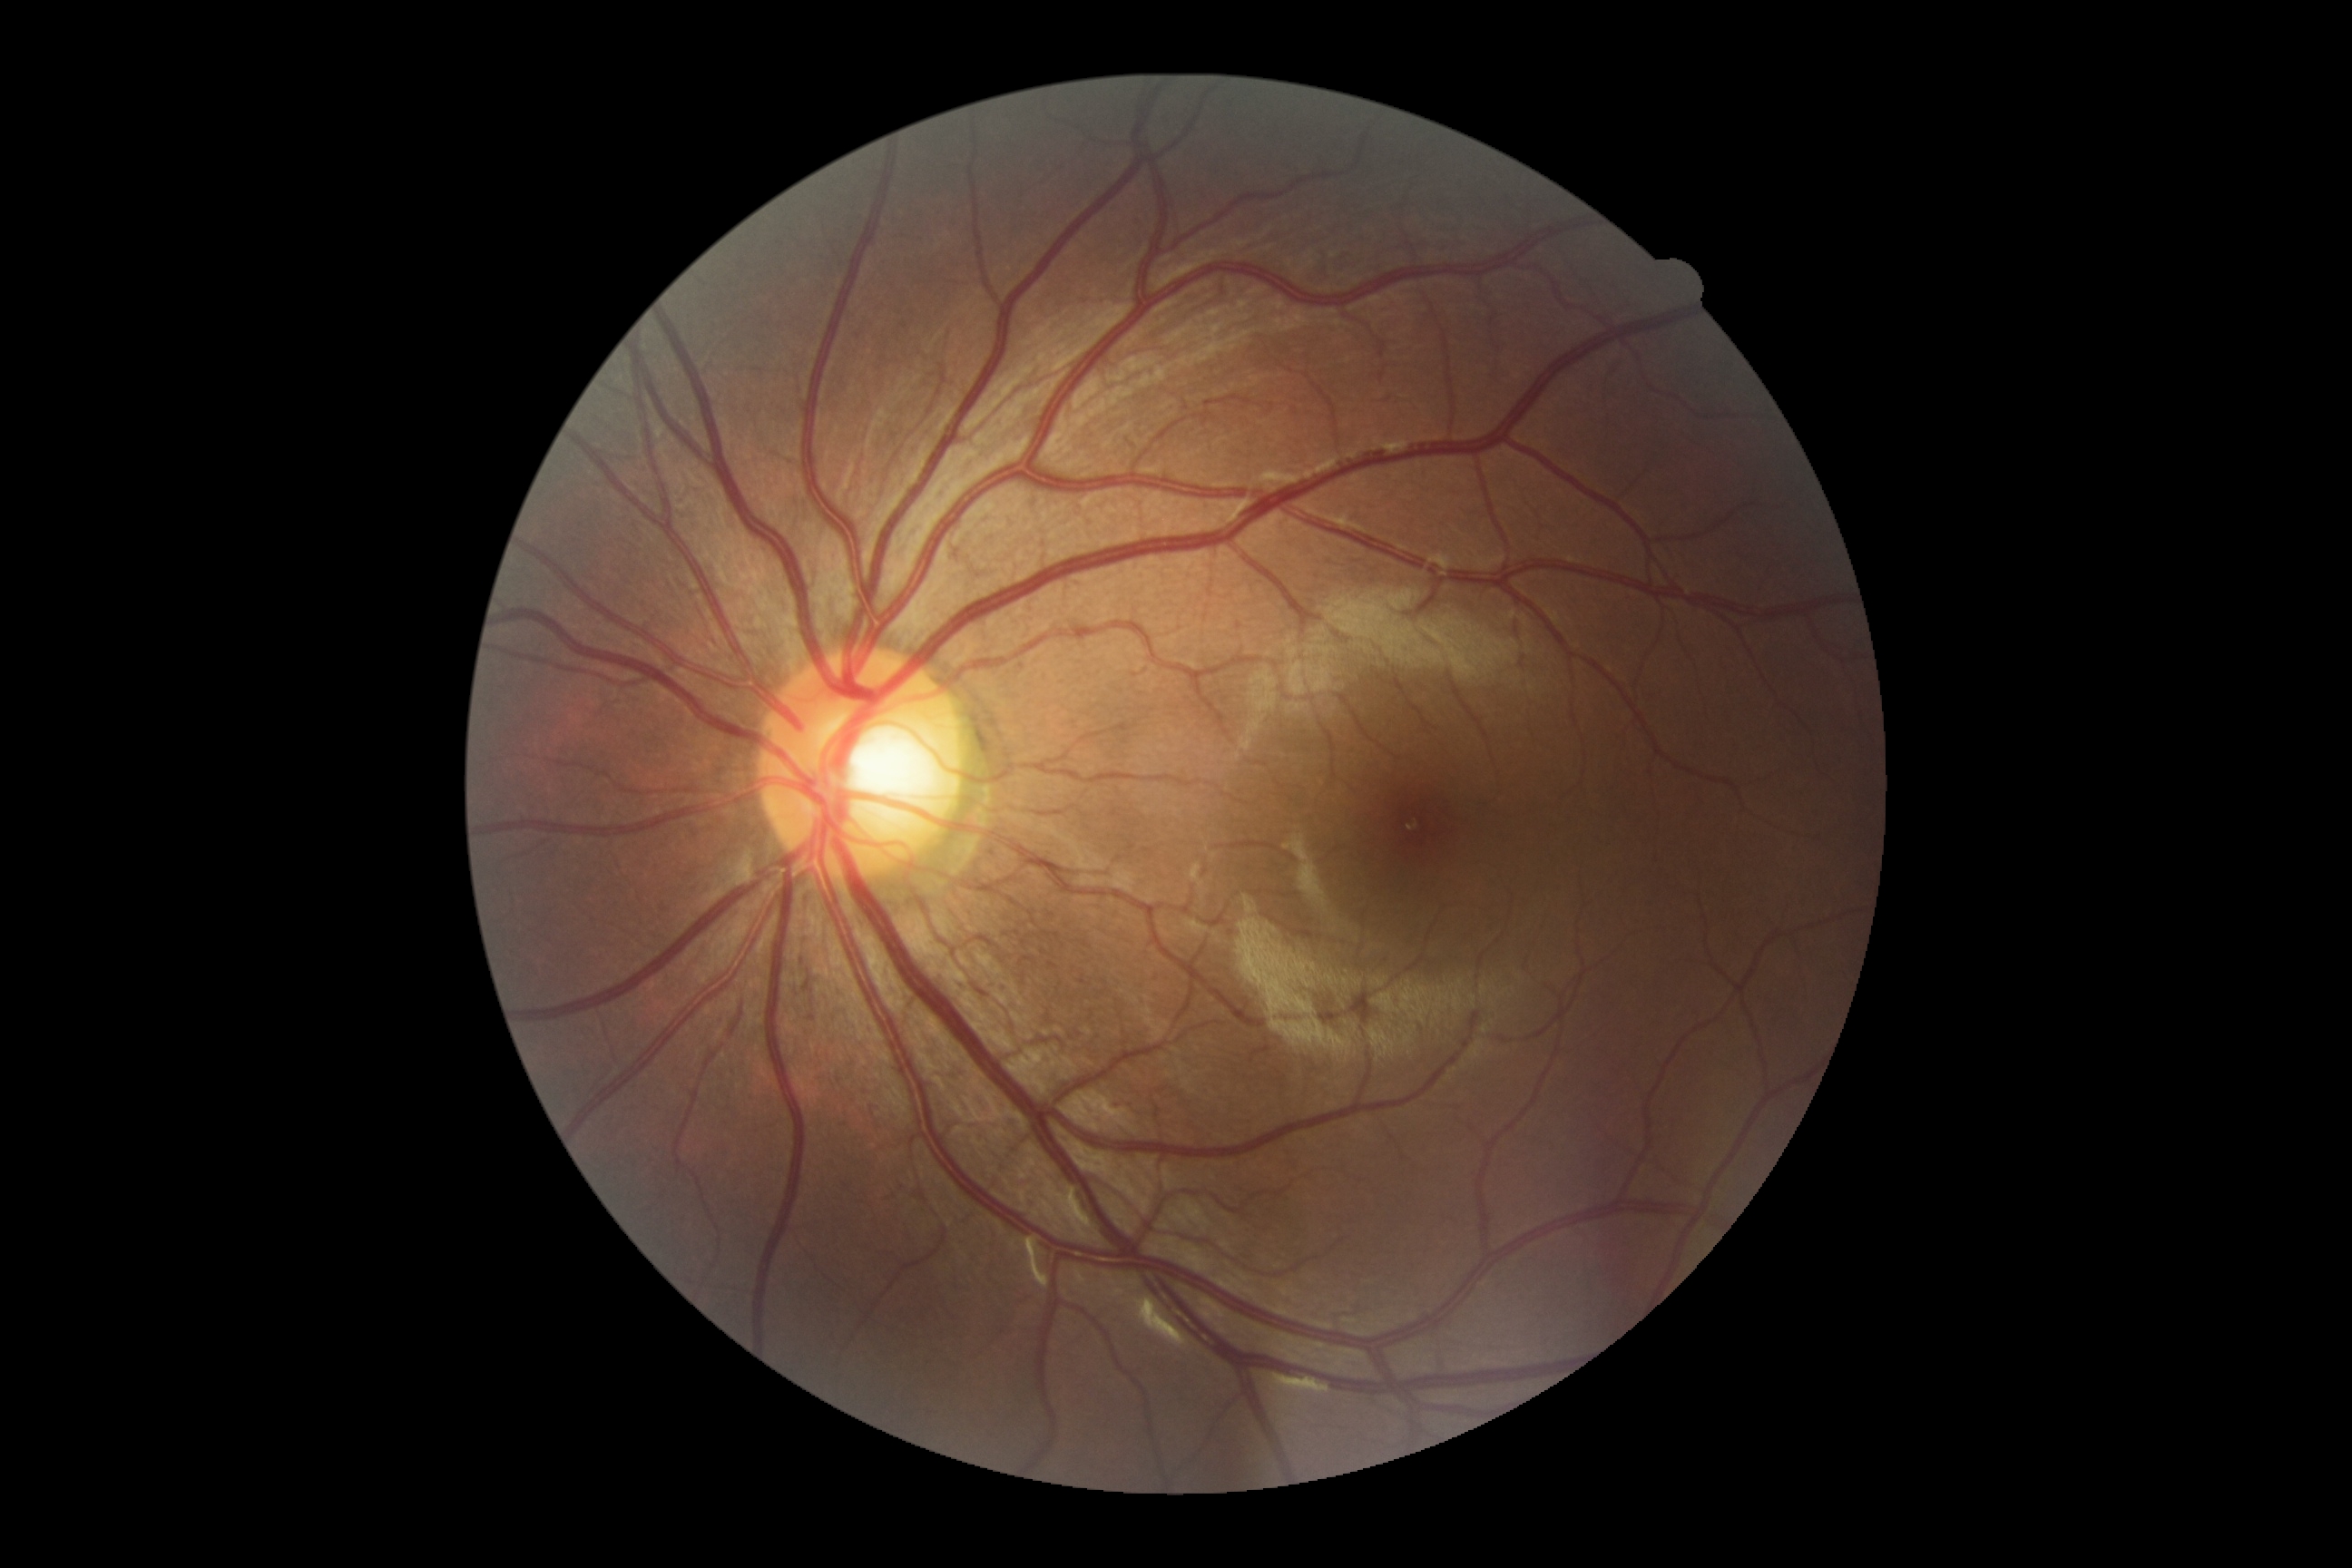
DR grade is 0 (no apparent retinopathy).